2352 x 1568 pixels, 45° field of view, retinal fundus photograph: 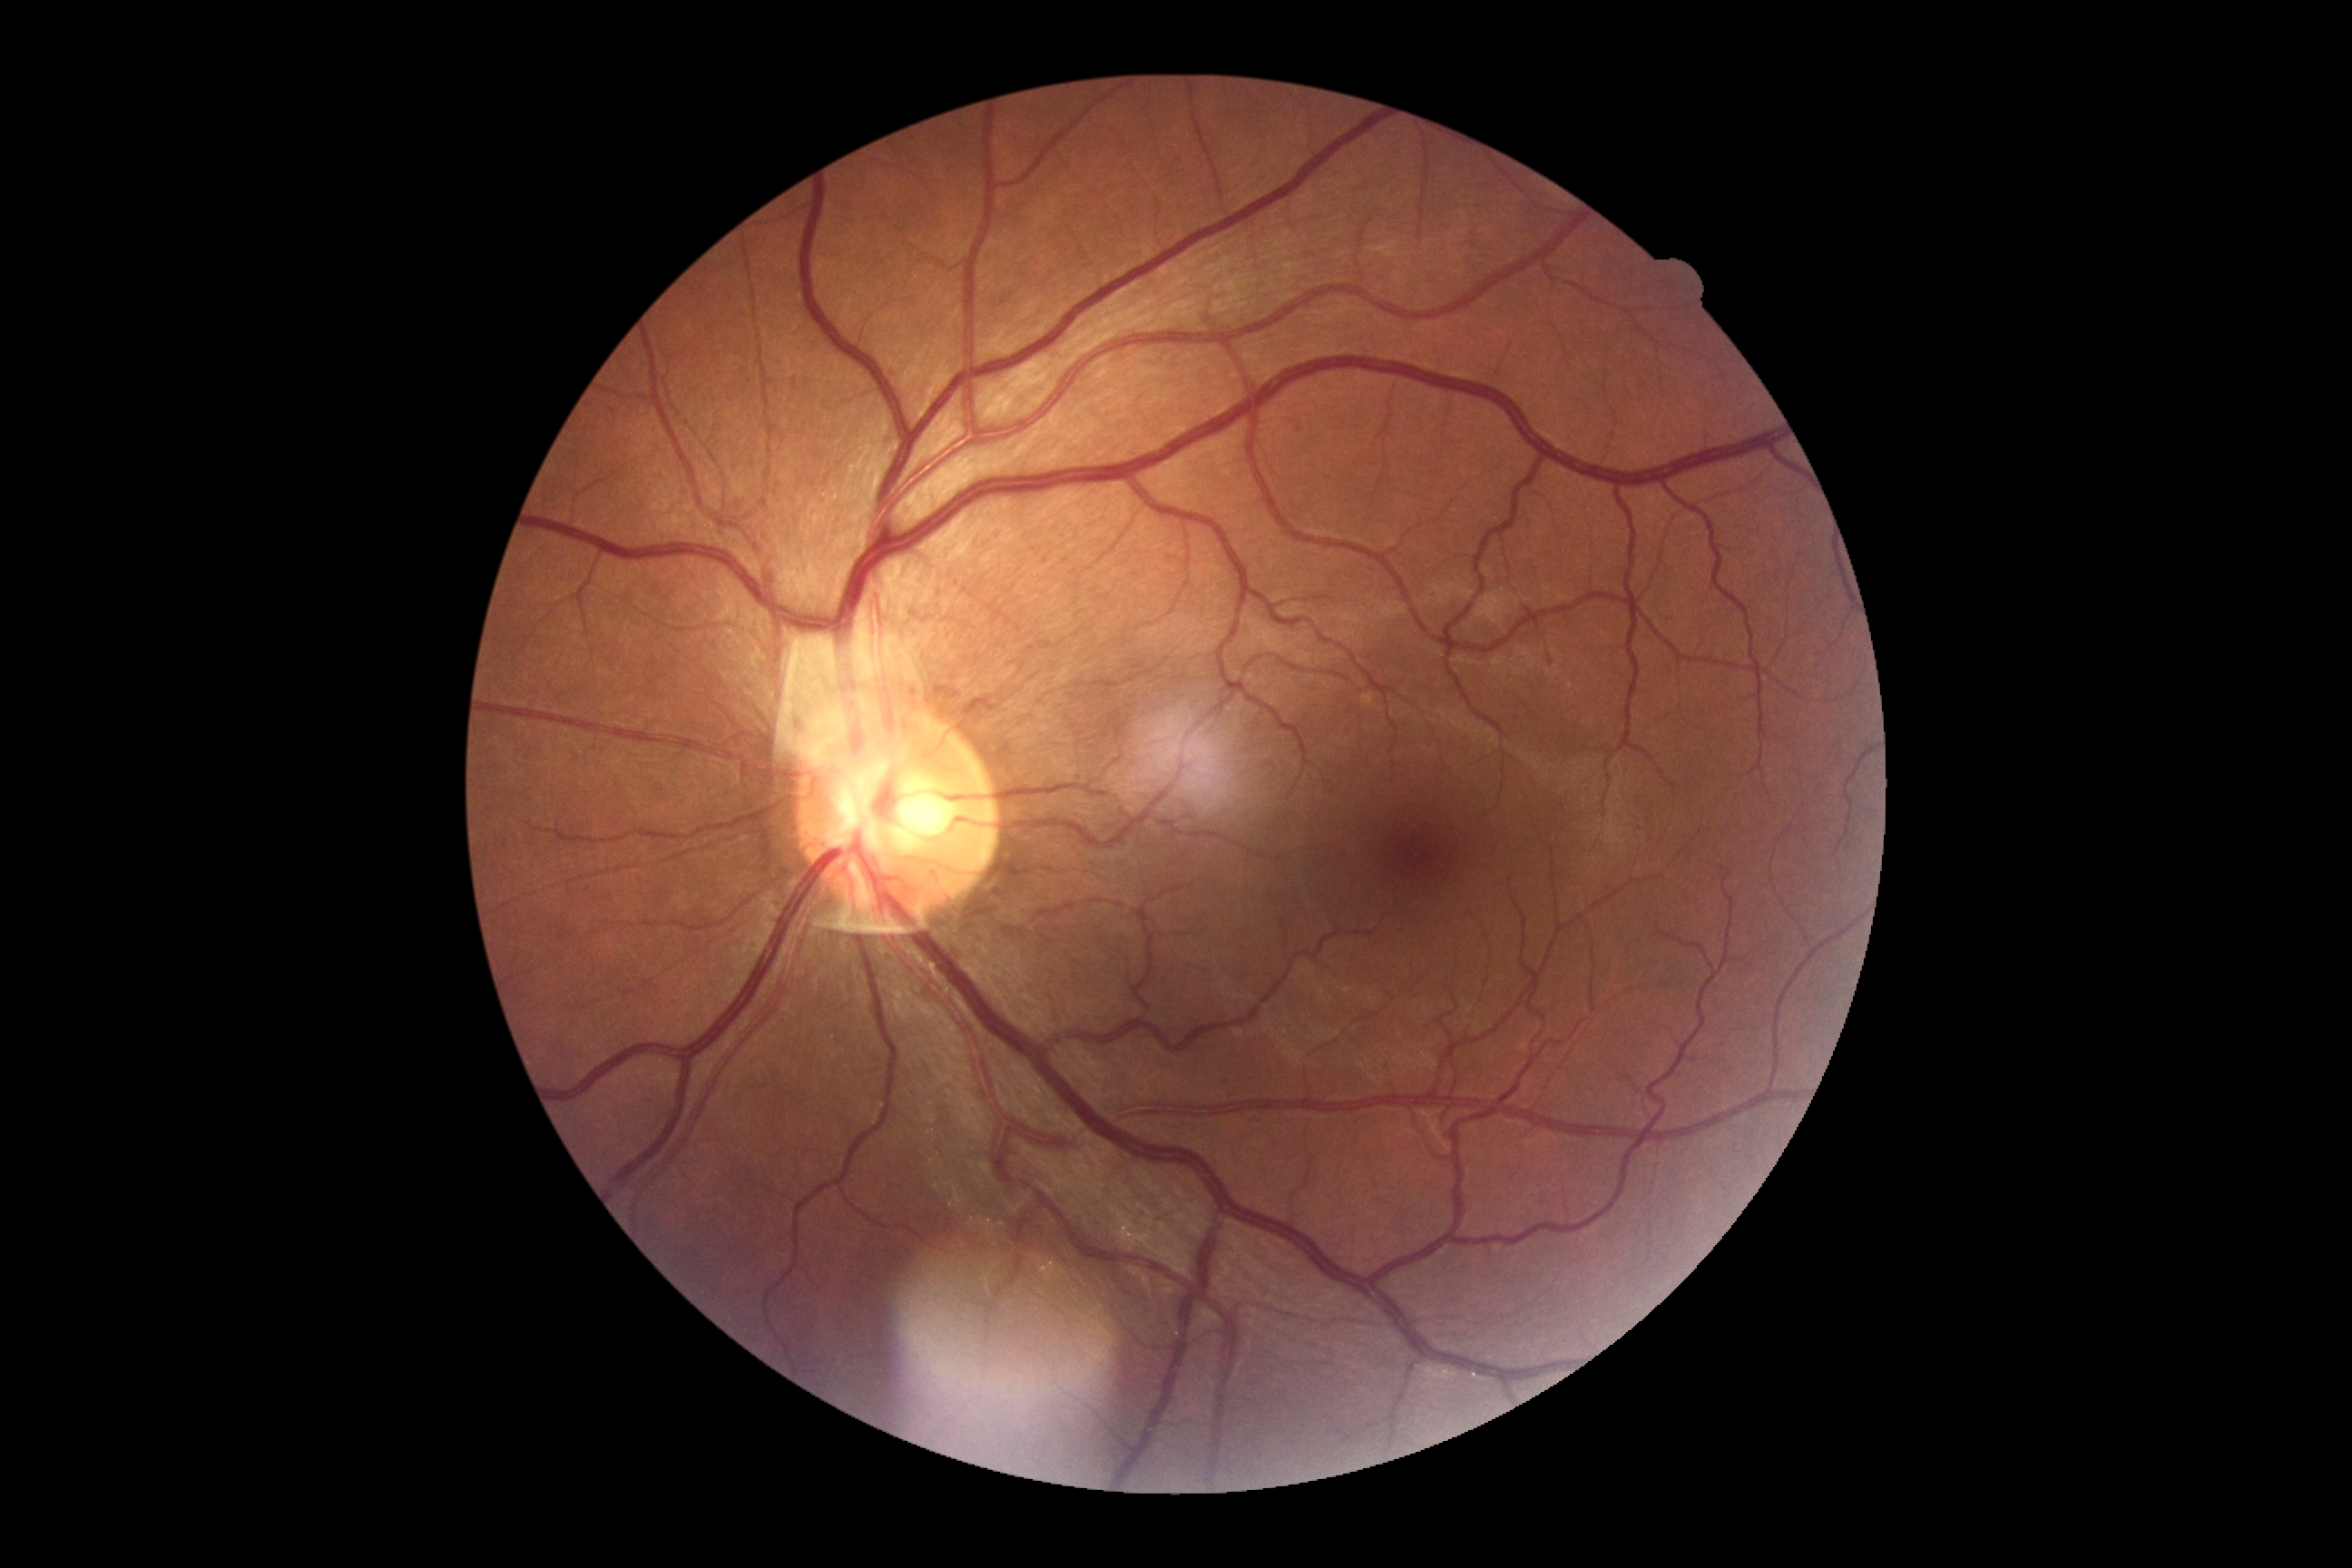 DR is grade 0 (no apparent retinopathy).
No apparent diabetic retinopathy.